1380 by 1382 pixels, 45° FOV.
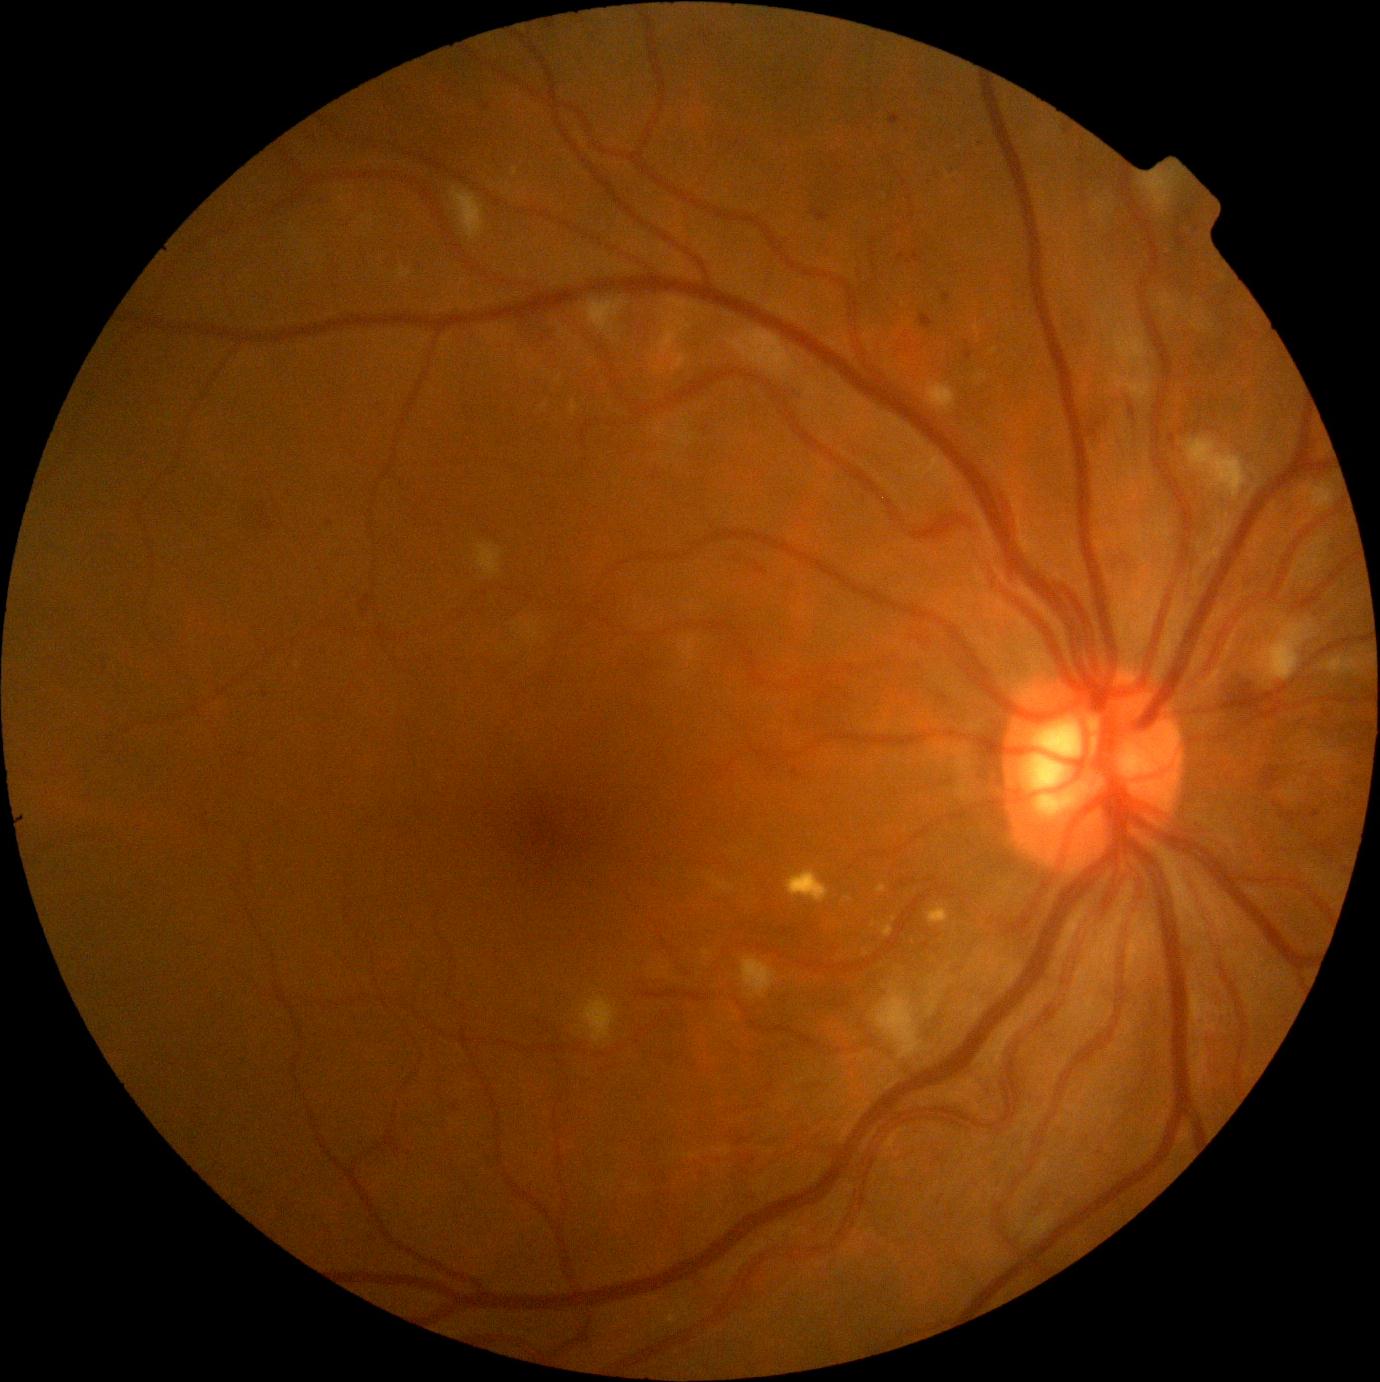 DR is moderate non-proliferative diabetic retinopathy (grade 2) — more than just microaneurysms but less than severe NPDR
Lesions identified (partial list):
MAs (more not shown): Rect(972, 138, 982, 142); Rect(964, 349, 973, 361); Rect(452, 1104, 460, 1111); Rect(889, 115, 900, 126); Rect(793, 768, 801, 779); Rect(946, 169, 954, 172); Rect(1170, 434, 1176, 445); Rect(811, 209, 830, 223); Rect(912, 251, 923, 263)
Small MAs approximately at [902,256]; [967,343]
EXs: Rect(876, 884, 887, 893); Rect(787, 870, 830, 904); Rect(881, 924, 893, 938); Rect(512, 168, 518, 177); Rect(556, 375, 562, 383); Rect(927, 905, 950, 925); Rect(570, 400, 580, 415)
Small EXs approximately at [849,899]; [874,924]; [544,407]; [894,920]
SEs: Rect(873, 990, 924, 1060); Rect(585, 301, 623, 333); Rect(1141, 174, 1174, 216); Rect(1257, 624, 1316, 683); Rect(1186, 438, 1248, 500); Rect(727, 329, 797, 379); Rect(1322, 656, 1361, 675); Rect(1110, 325, 1151, 402); Rect(1303, 484, 1334, 511); Rect(927, 383, 957, 411); Rect(477, 544, 503, 577); Rect(581, 997, 616, 1044); Rect(741, 956, 778, 999); Rect(452, 188, 484, 242)
Small SEs approximately at [1141,364]
HEs (more not shown): Rect(358, 590, 368, 614); Rect(1083, 423, 1108, 444); Rect(1233, 686, 1258, 703); Rect(1326, 727, 1365, 742); Rect(1281, 806, 1295, 819); Rect(522, 318, 555, 341); Rect(1262, 766, 1281, 791); Rect(1126, 399, 1141, 439); Rect(243, 495, 270, 528); Rect(1117, 554, 1139, 566)
Small HEs approximately at [1143,443]